1240x1240px; Phoenix ICON wide-field infant fundus image — 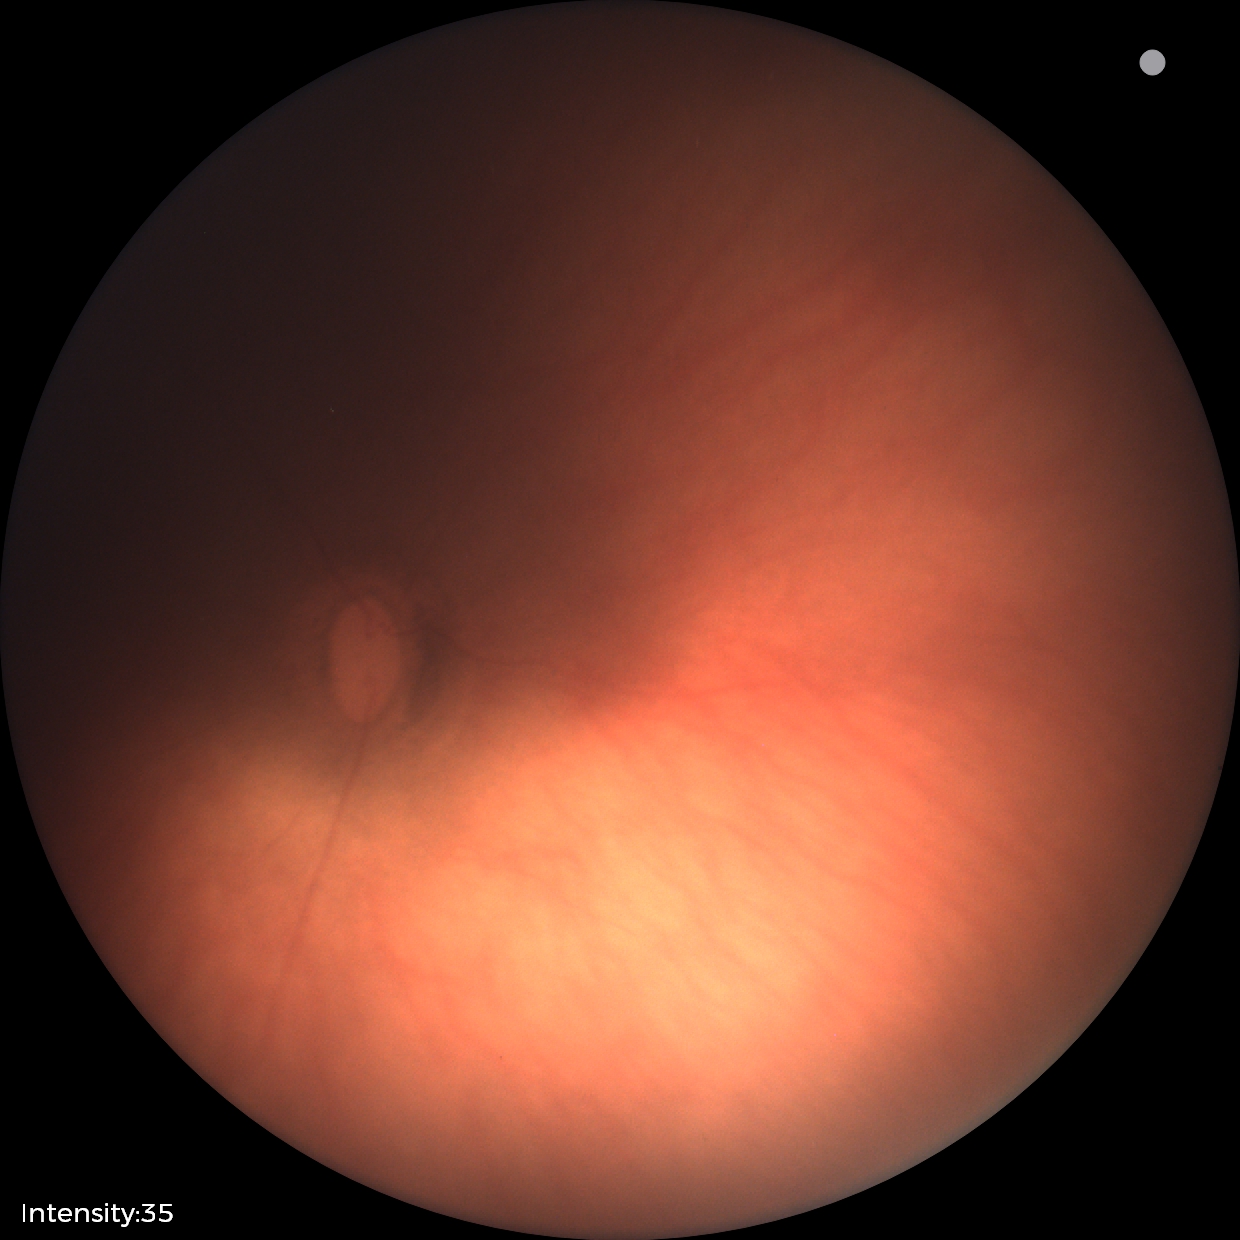

No retinal pathology identified on screening.